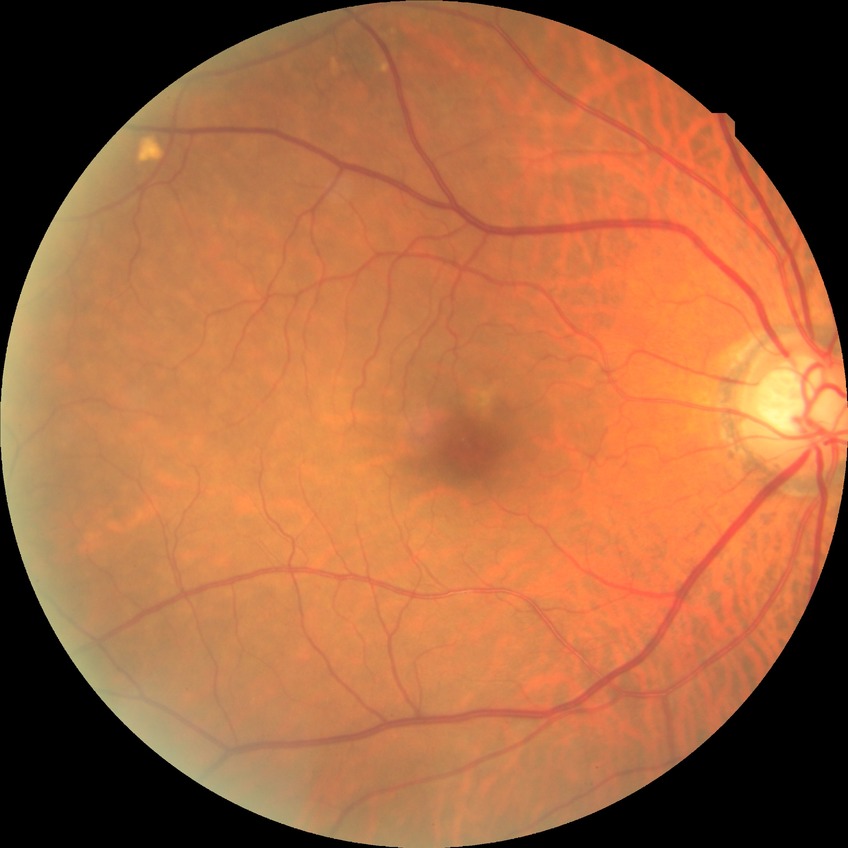
Davis grading: no diabetic retinopathy.